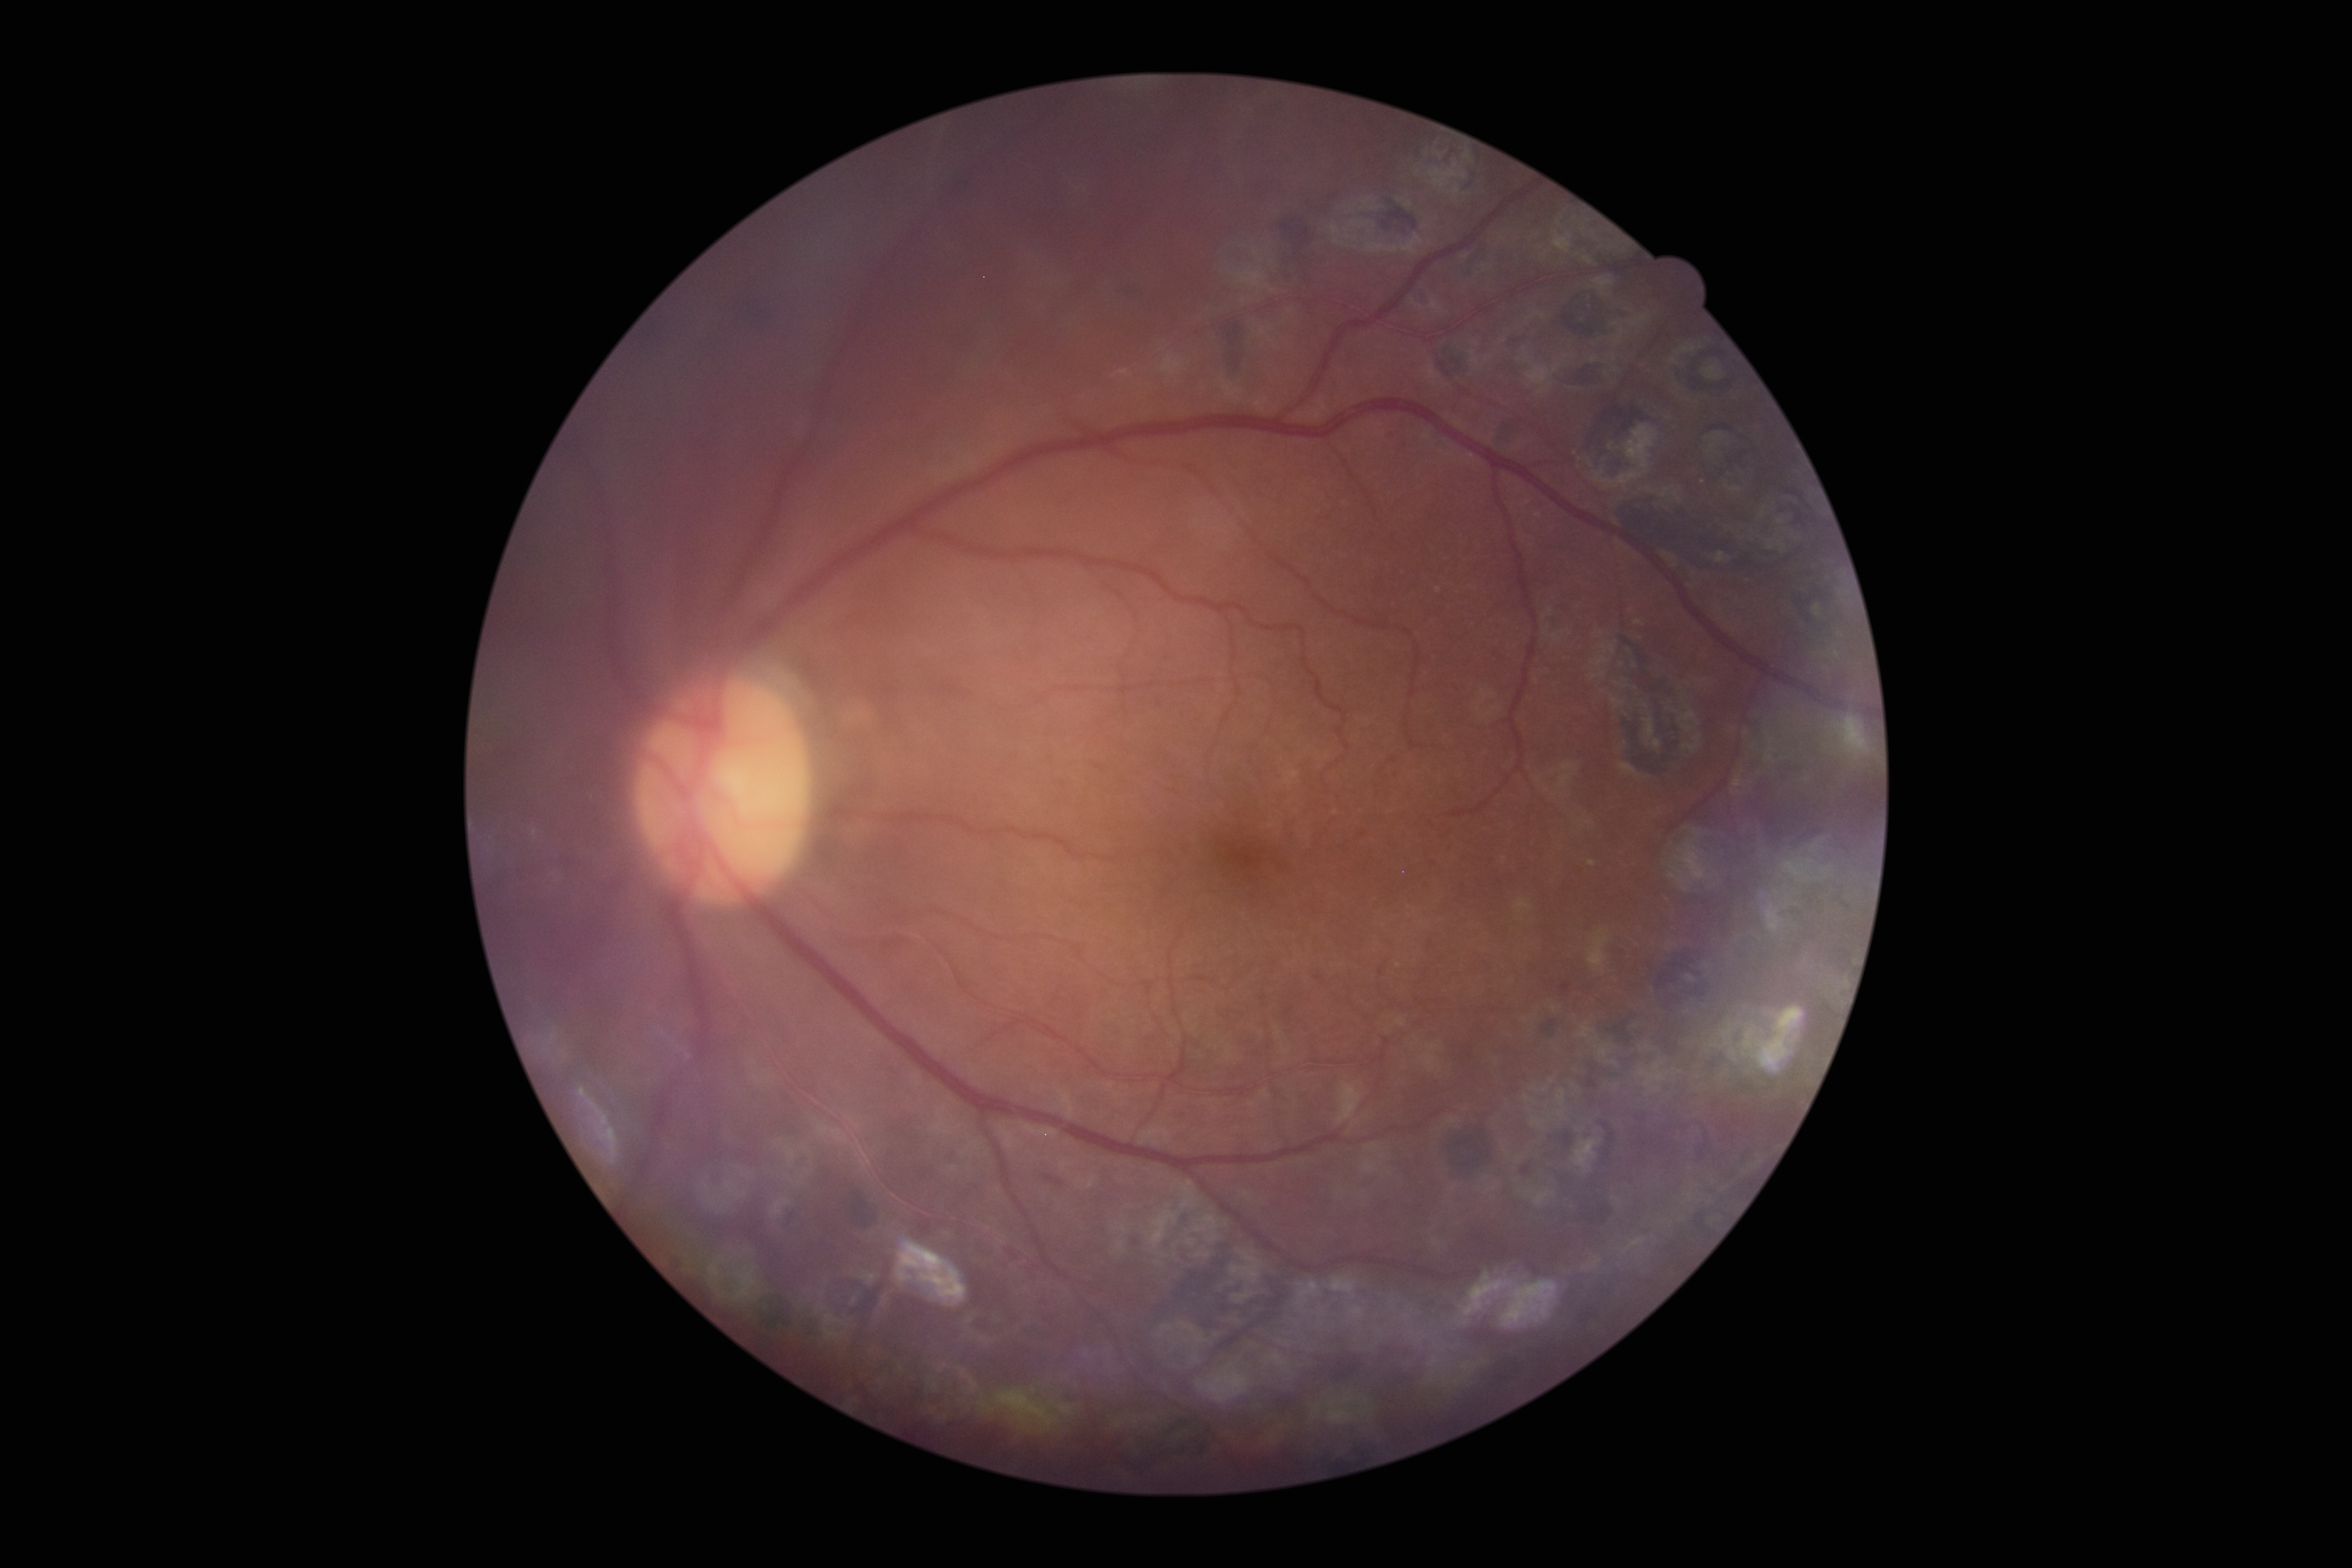 Annotations:
- DR class: non-proliferative diabetic retinopathy
- DR grade: 1